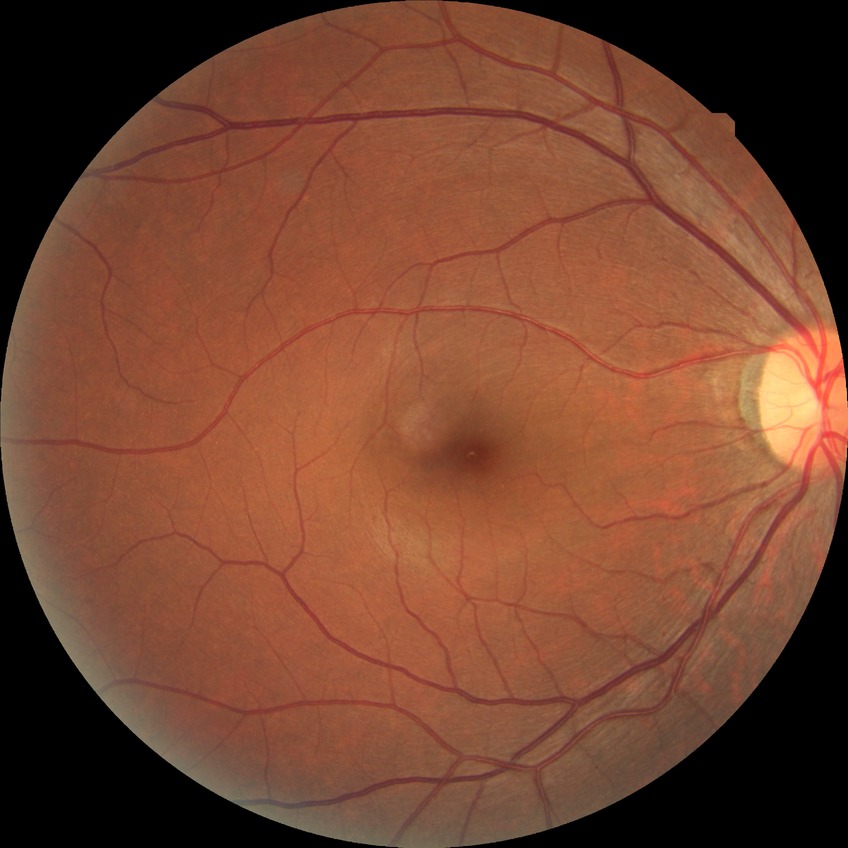

Diabetic retinopathy stage is no diabetic retinopathy.